Color fundus photograph
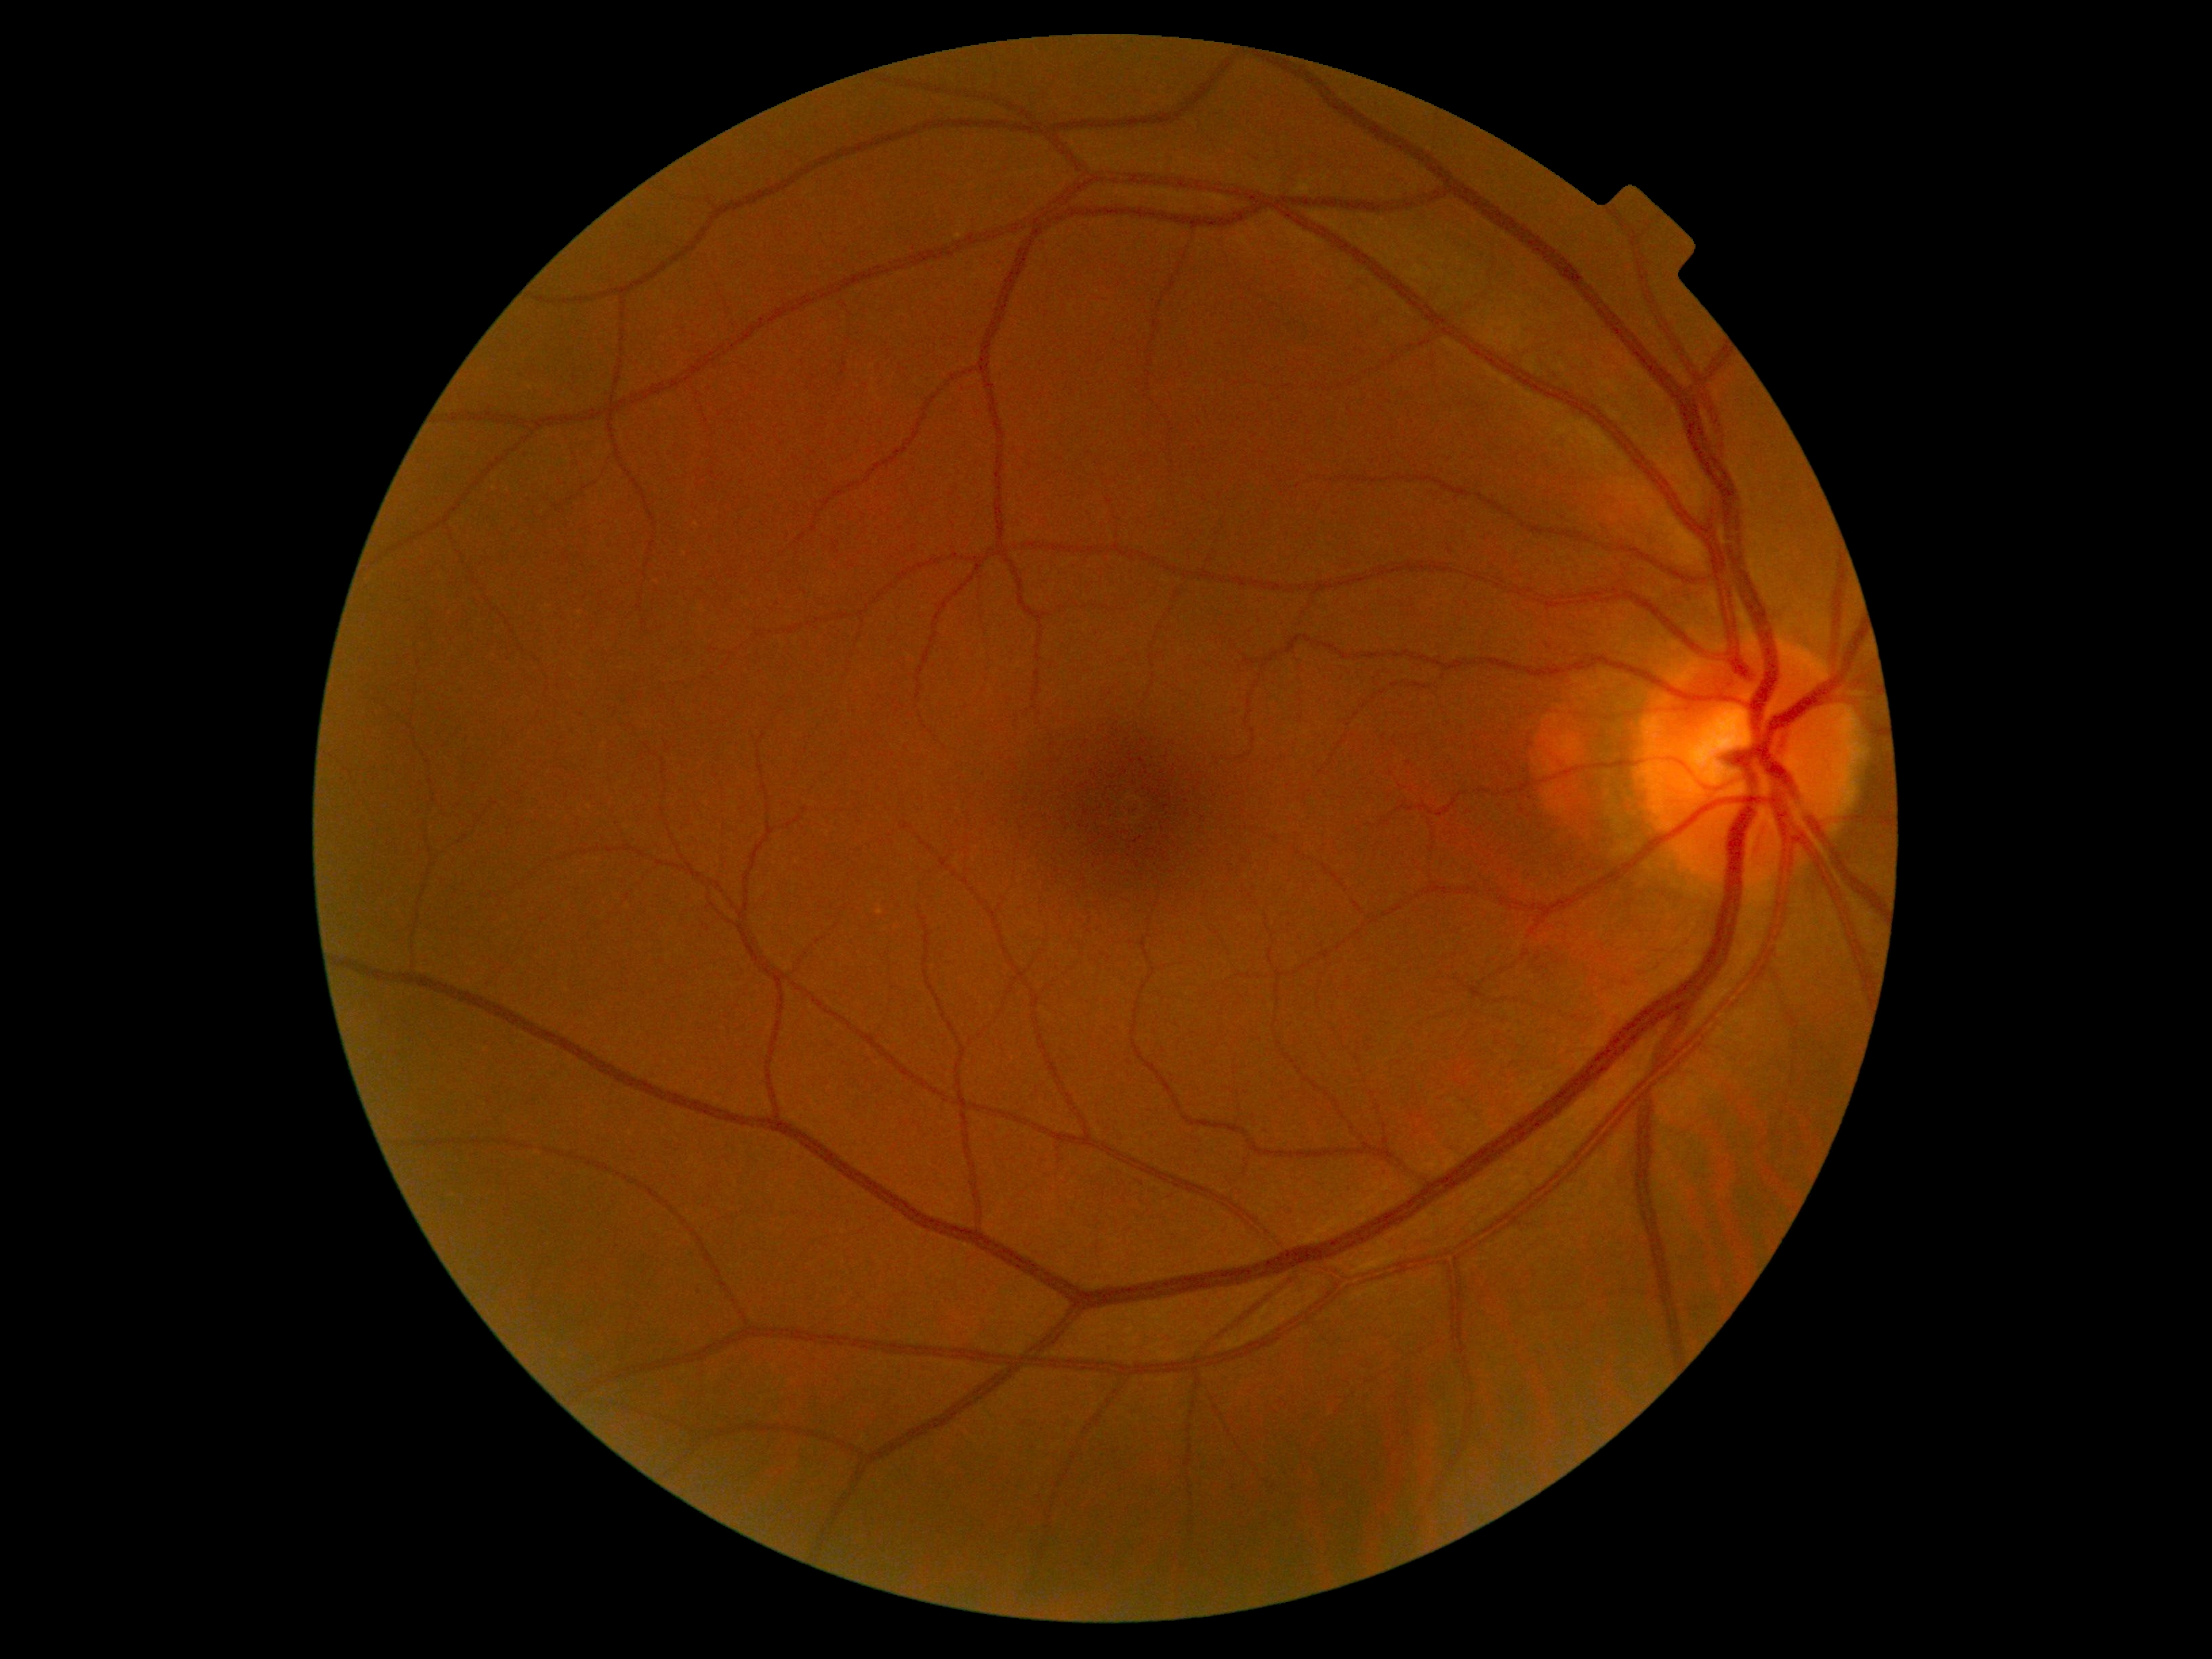

• diabetic retinopathy (DR) — grade 0